Pediatric retinal photograph (wide-field):
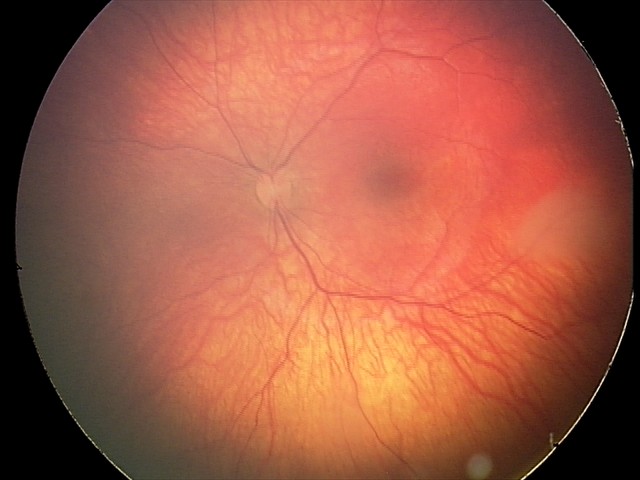

Examination diagnosed as retinal astrocytic hamartoma.